45 degree fundus photograph · retinal fundus photograph · no pharmacologic dilation · 848 x 848 pixels · acquired with a NIDEK AFC-230:
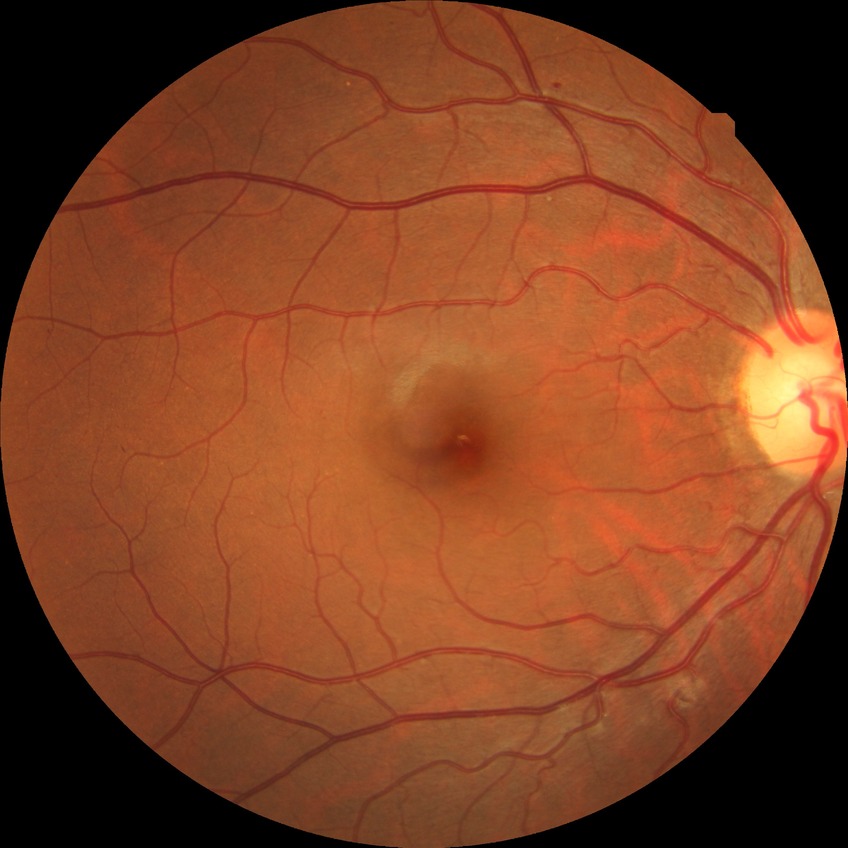
Annotations:
- modified Davis classification — simple diabetic retinopathy